Color fundus image · 2352x1568px · 45° field of view: 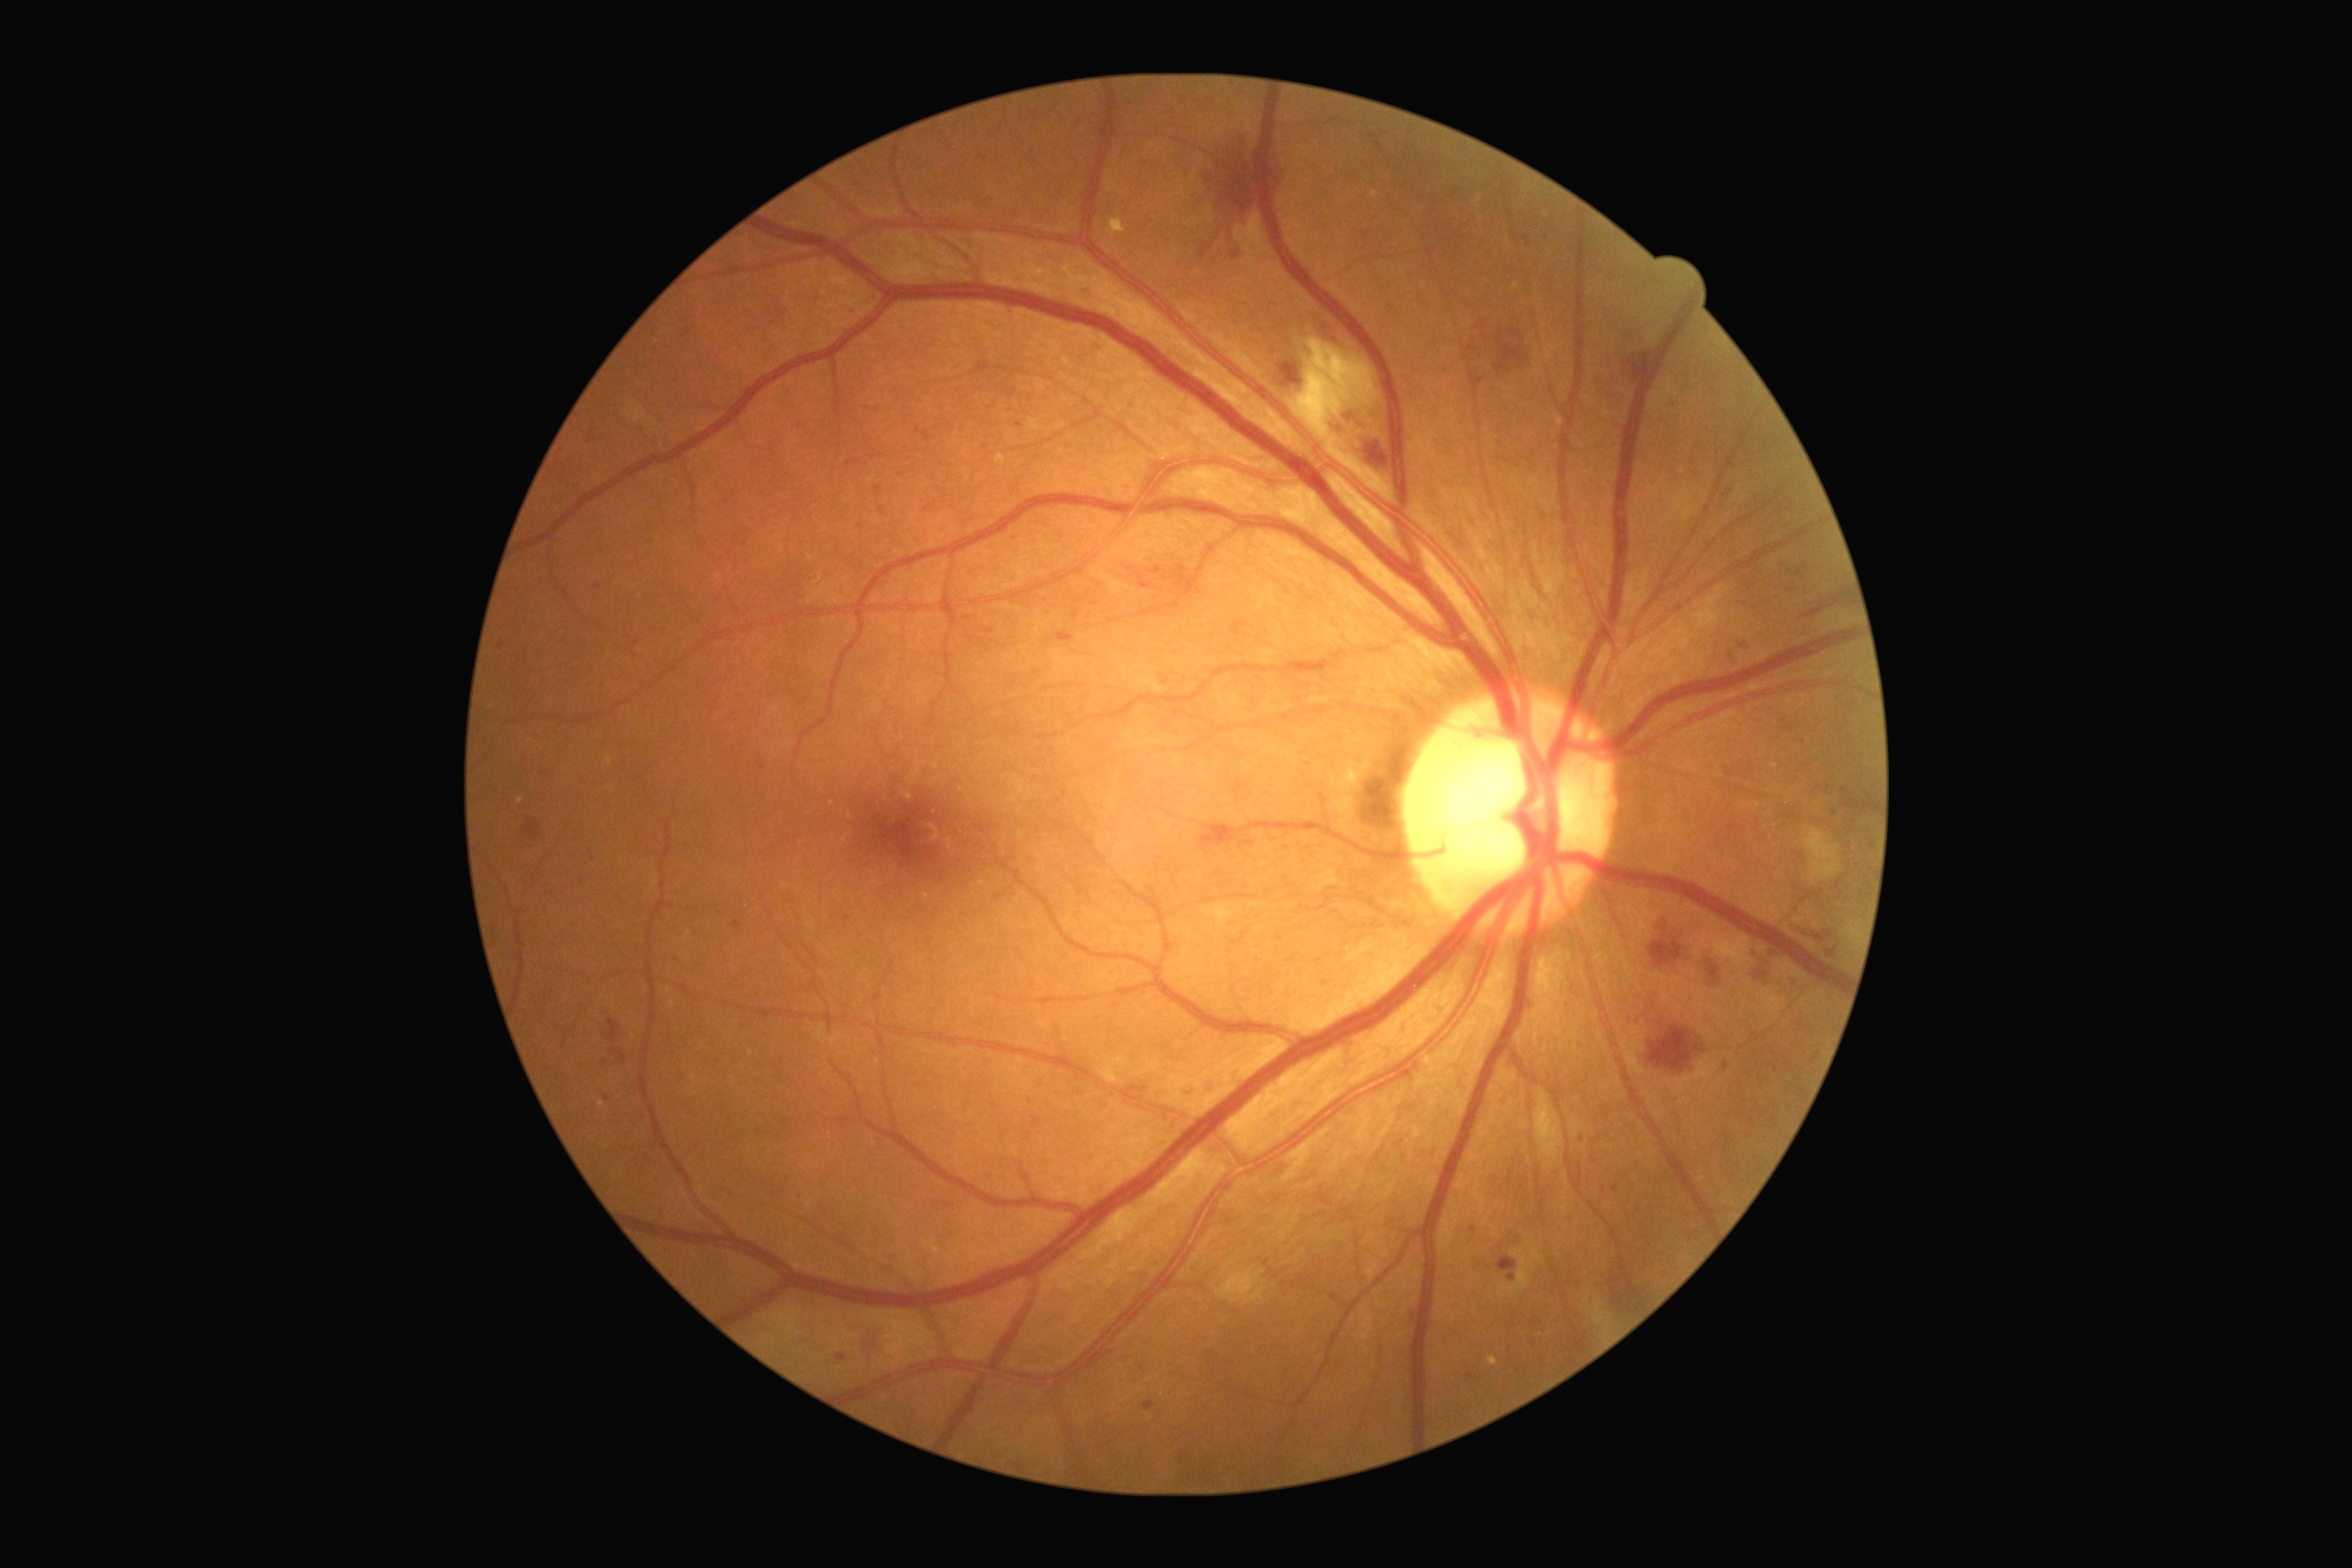
Diabetic retinopathy (DR): 2/4.